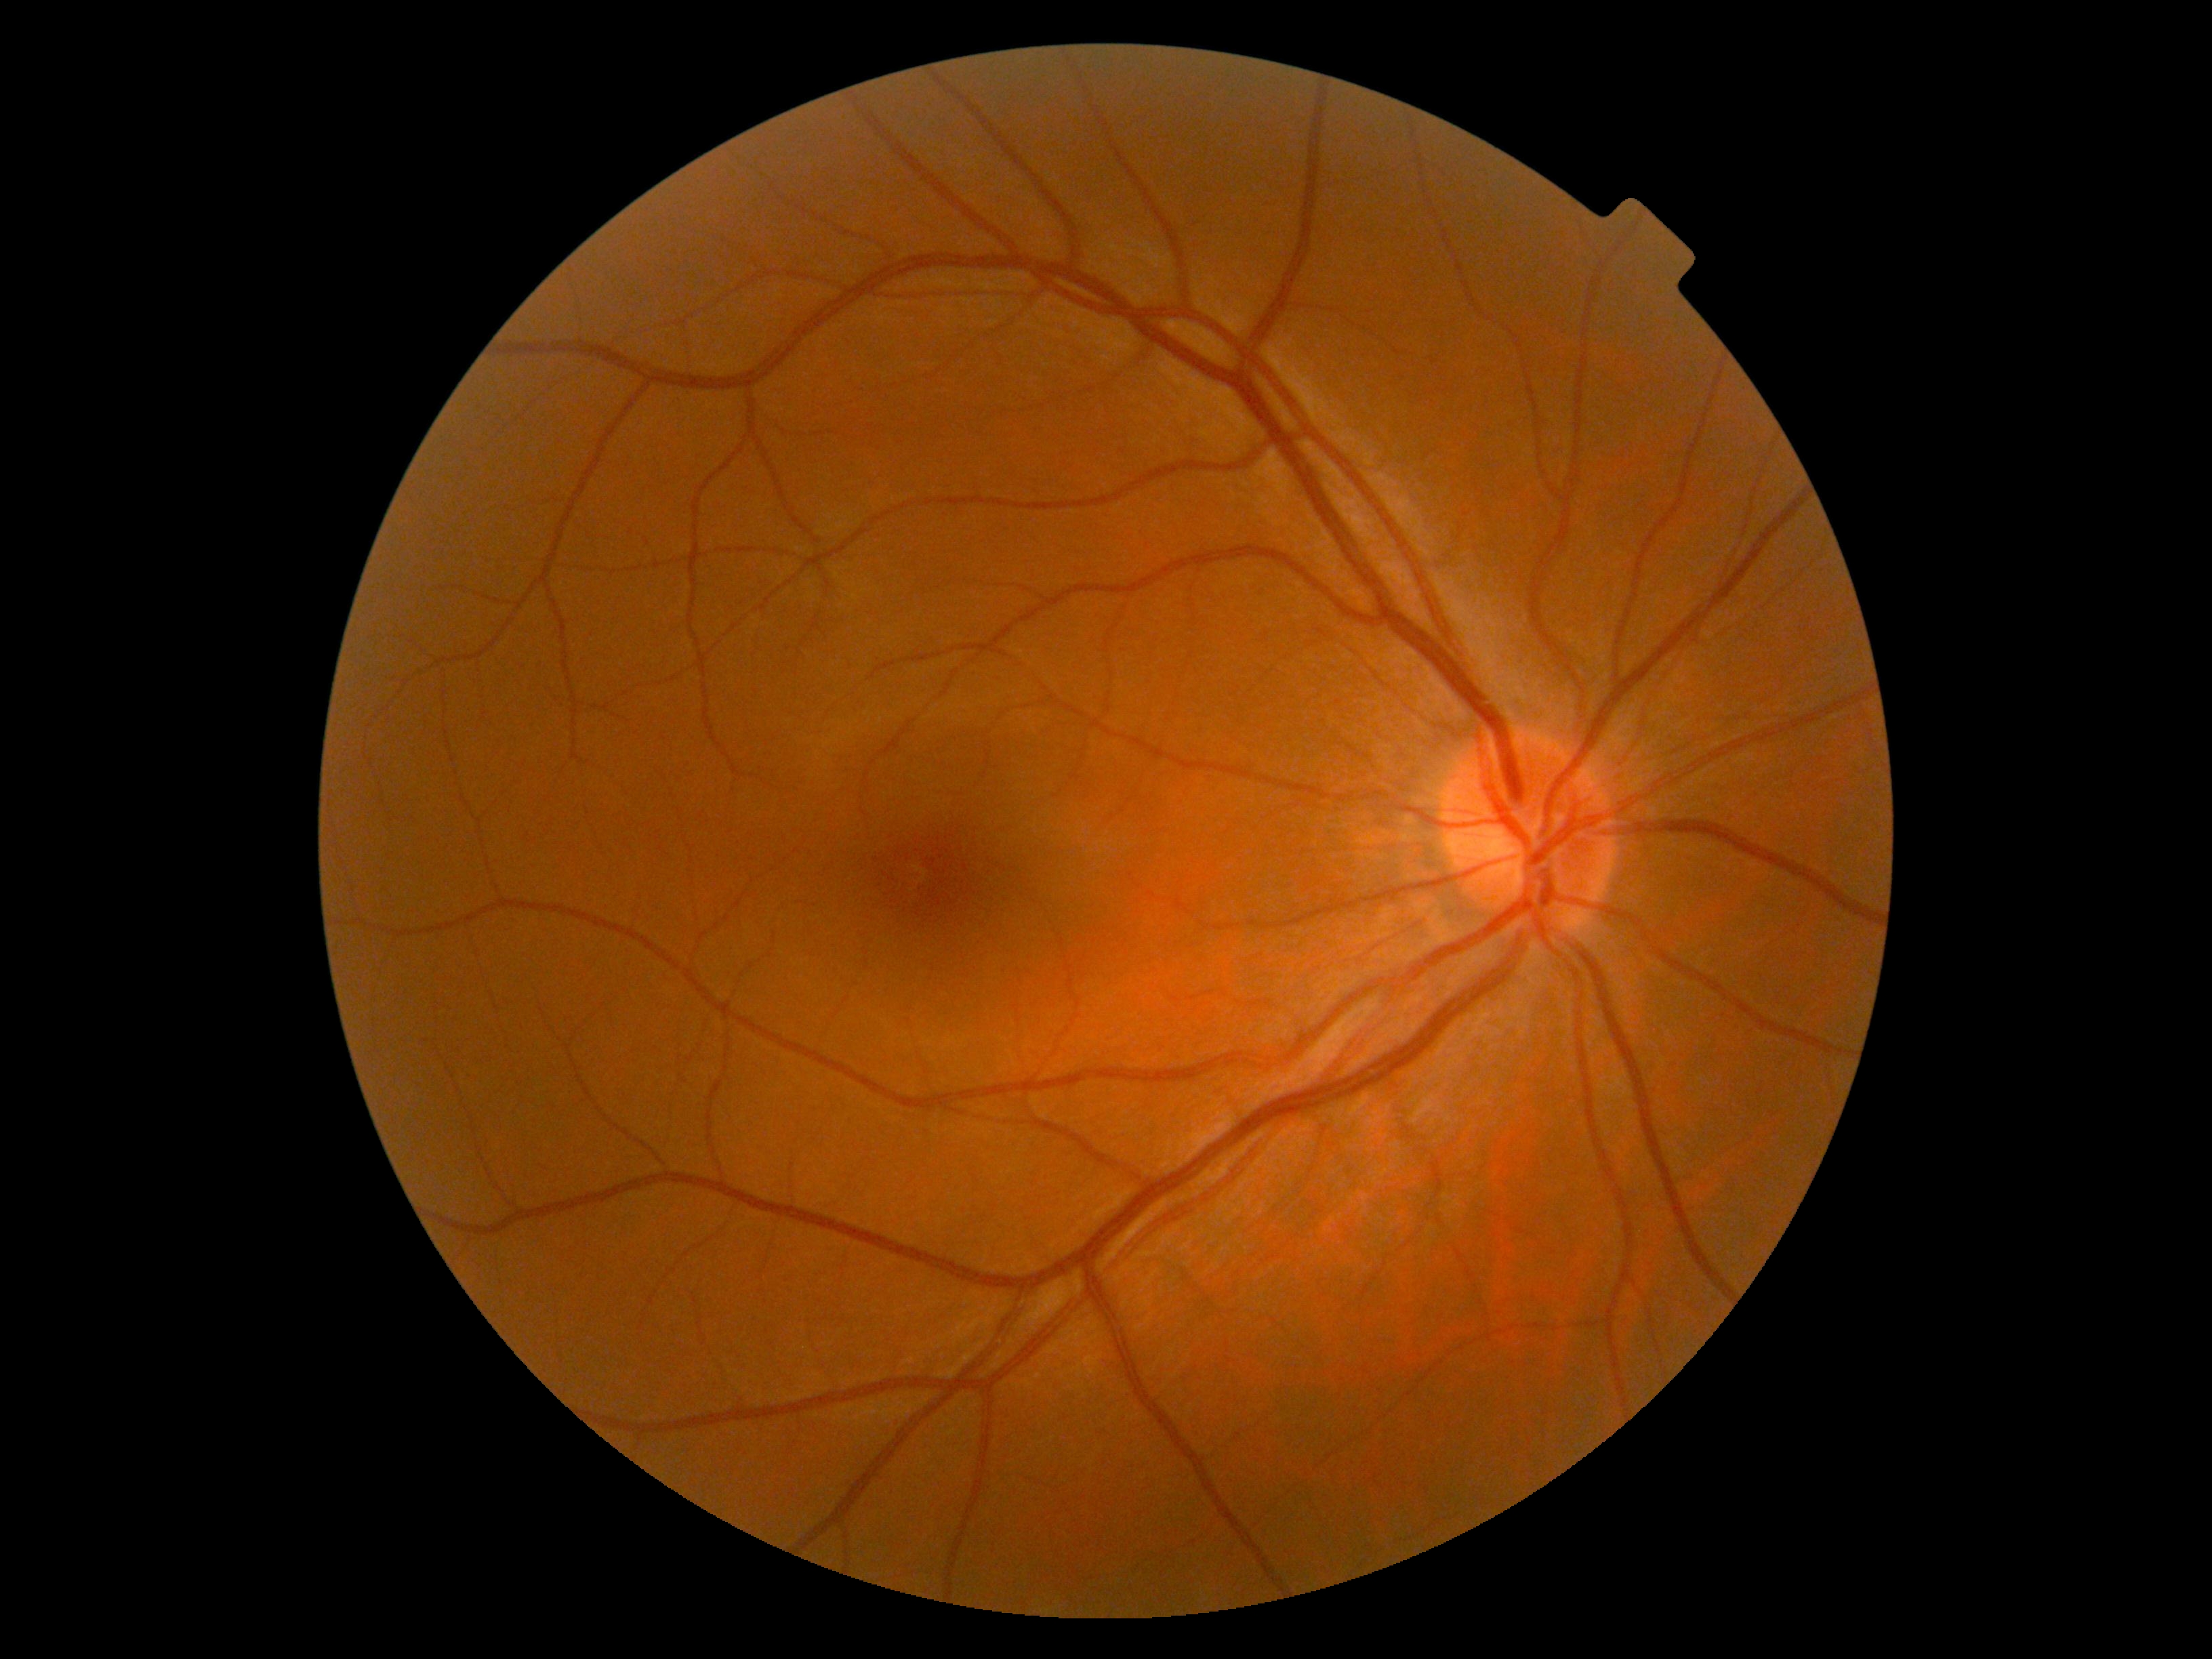 DR grade: no apparent diabetic retinopathy (0) — no visible signs of diabetic retinopathy.